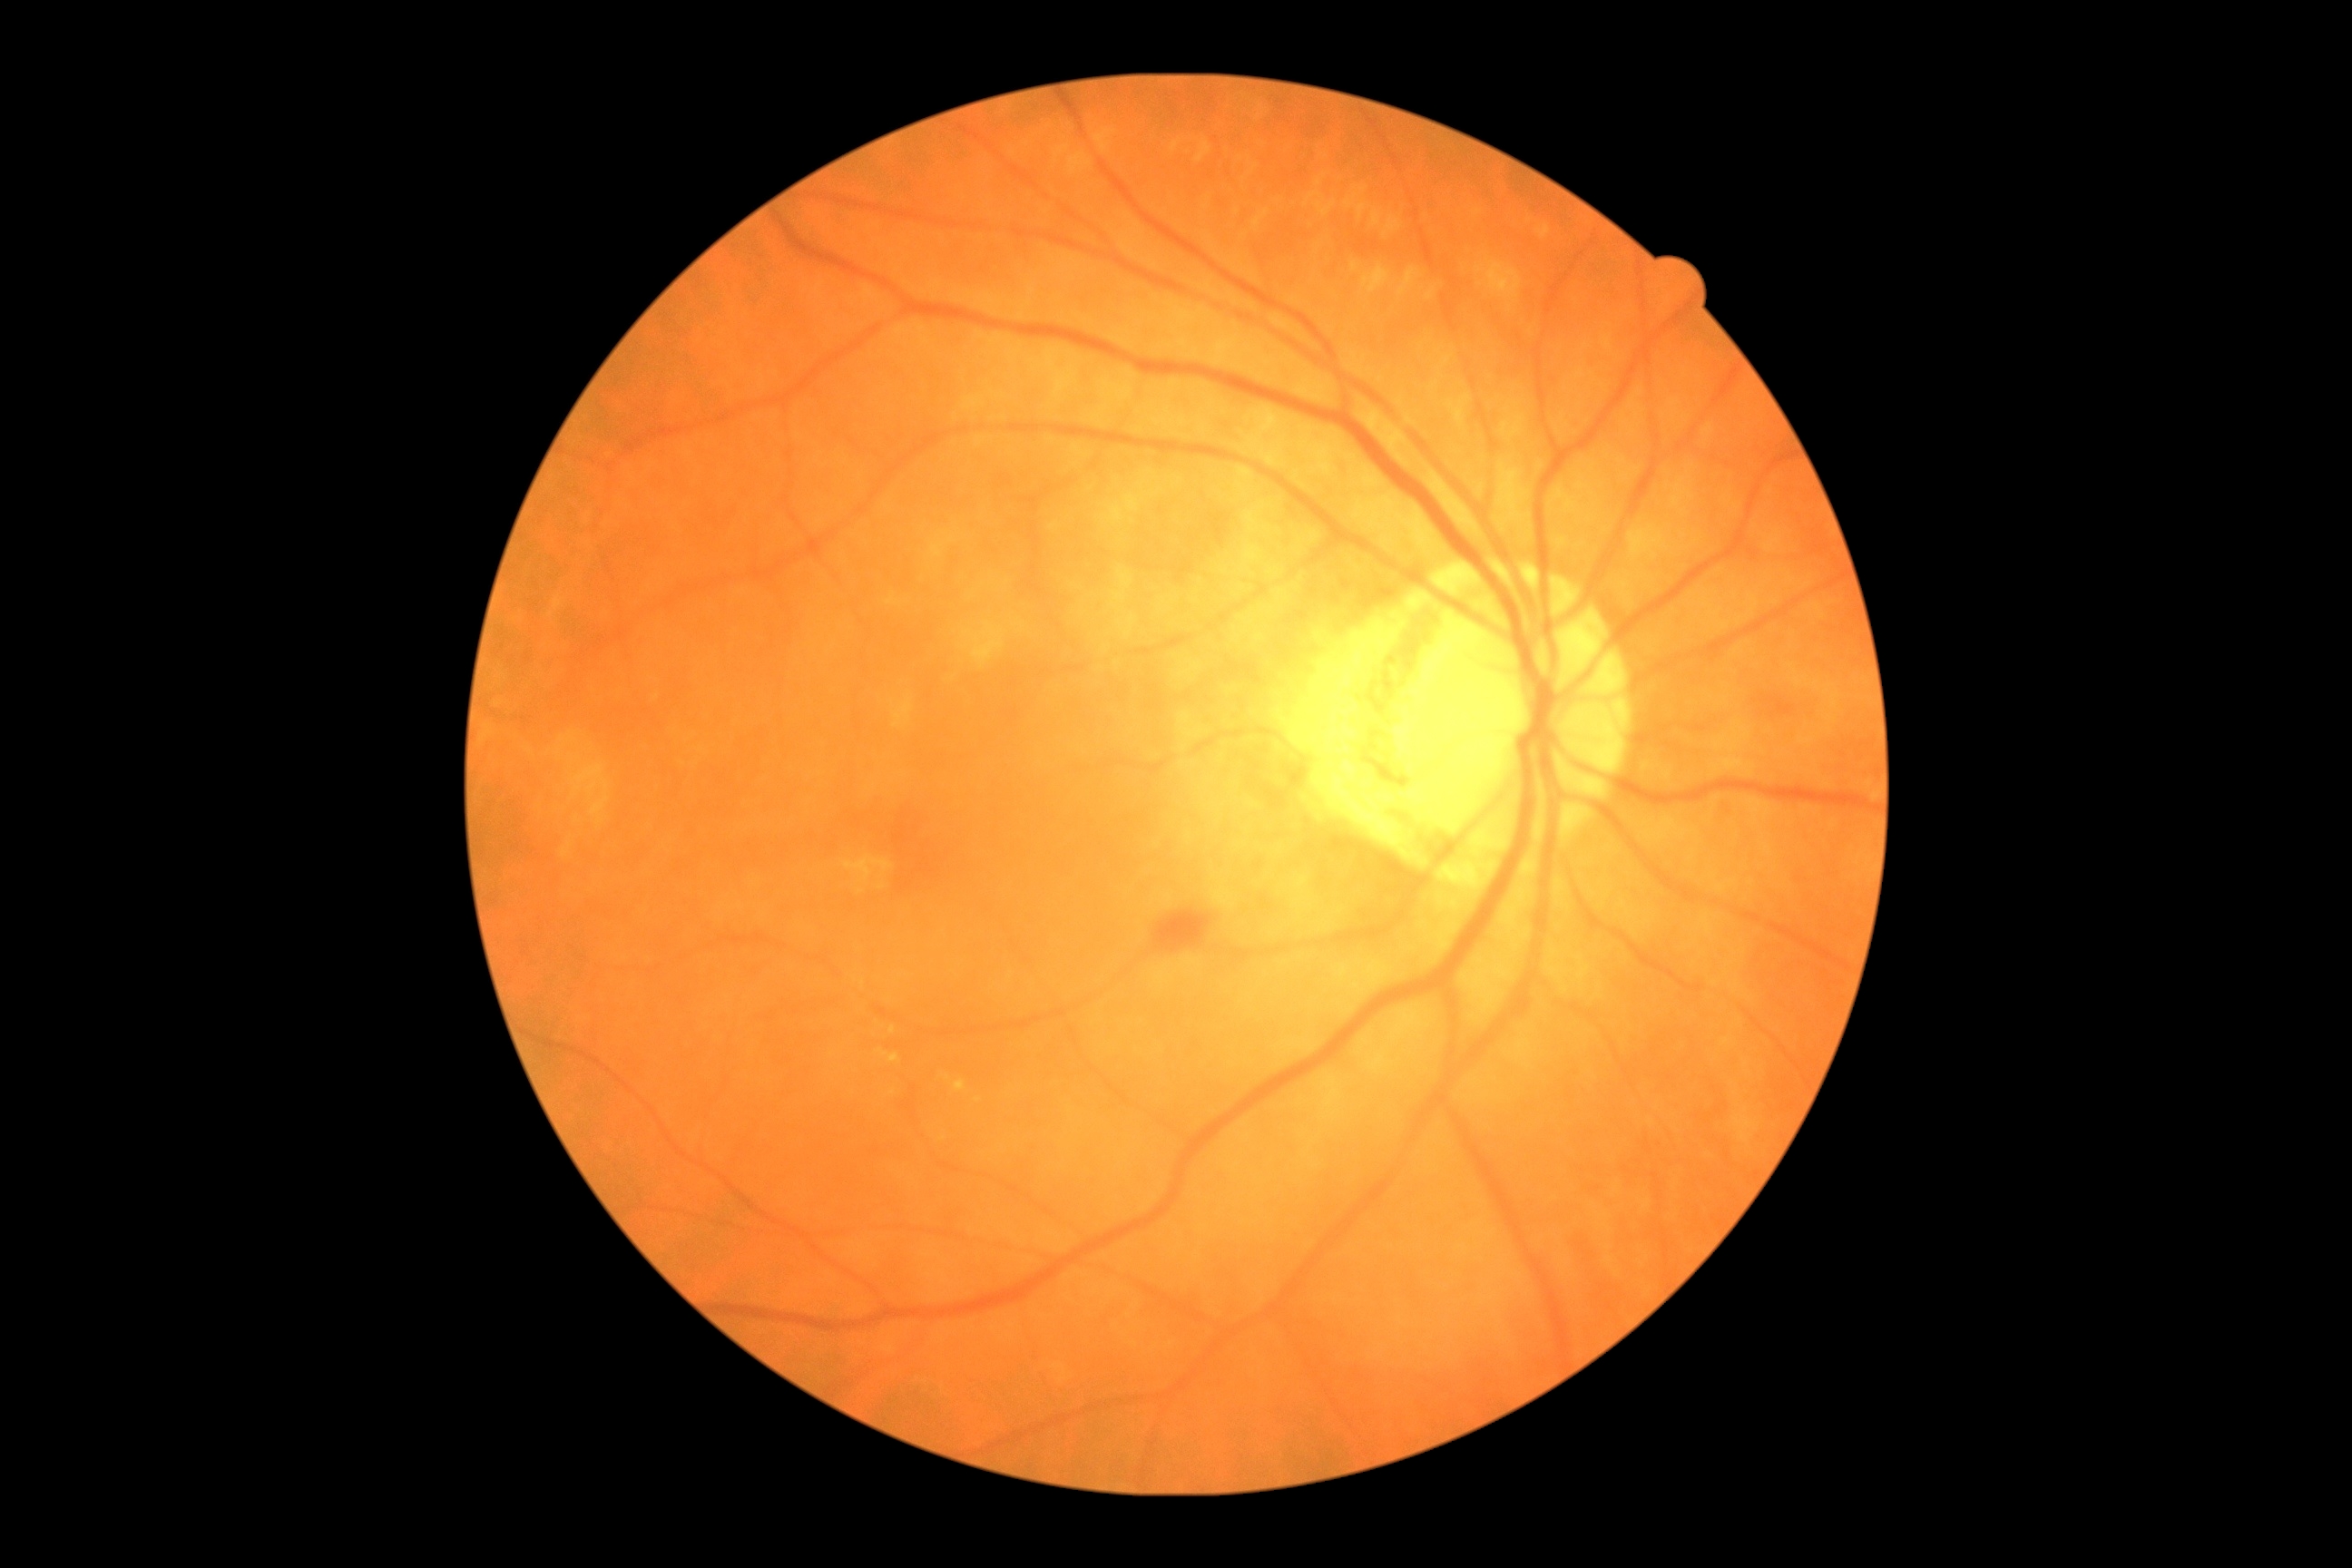
diabetic retinopathy: grade 2 (moderate NPDR).